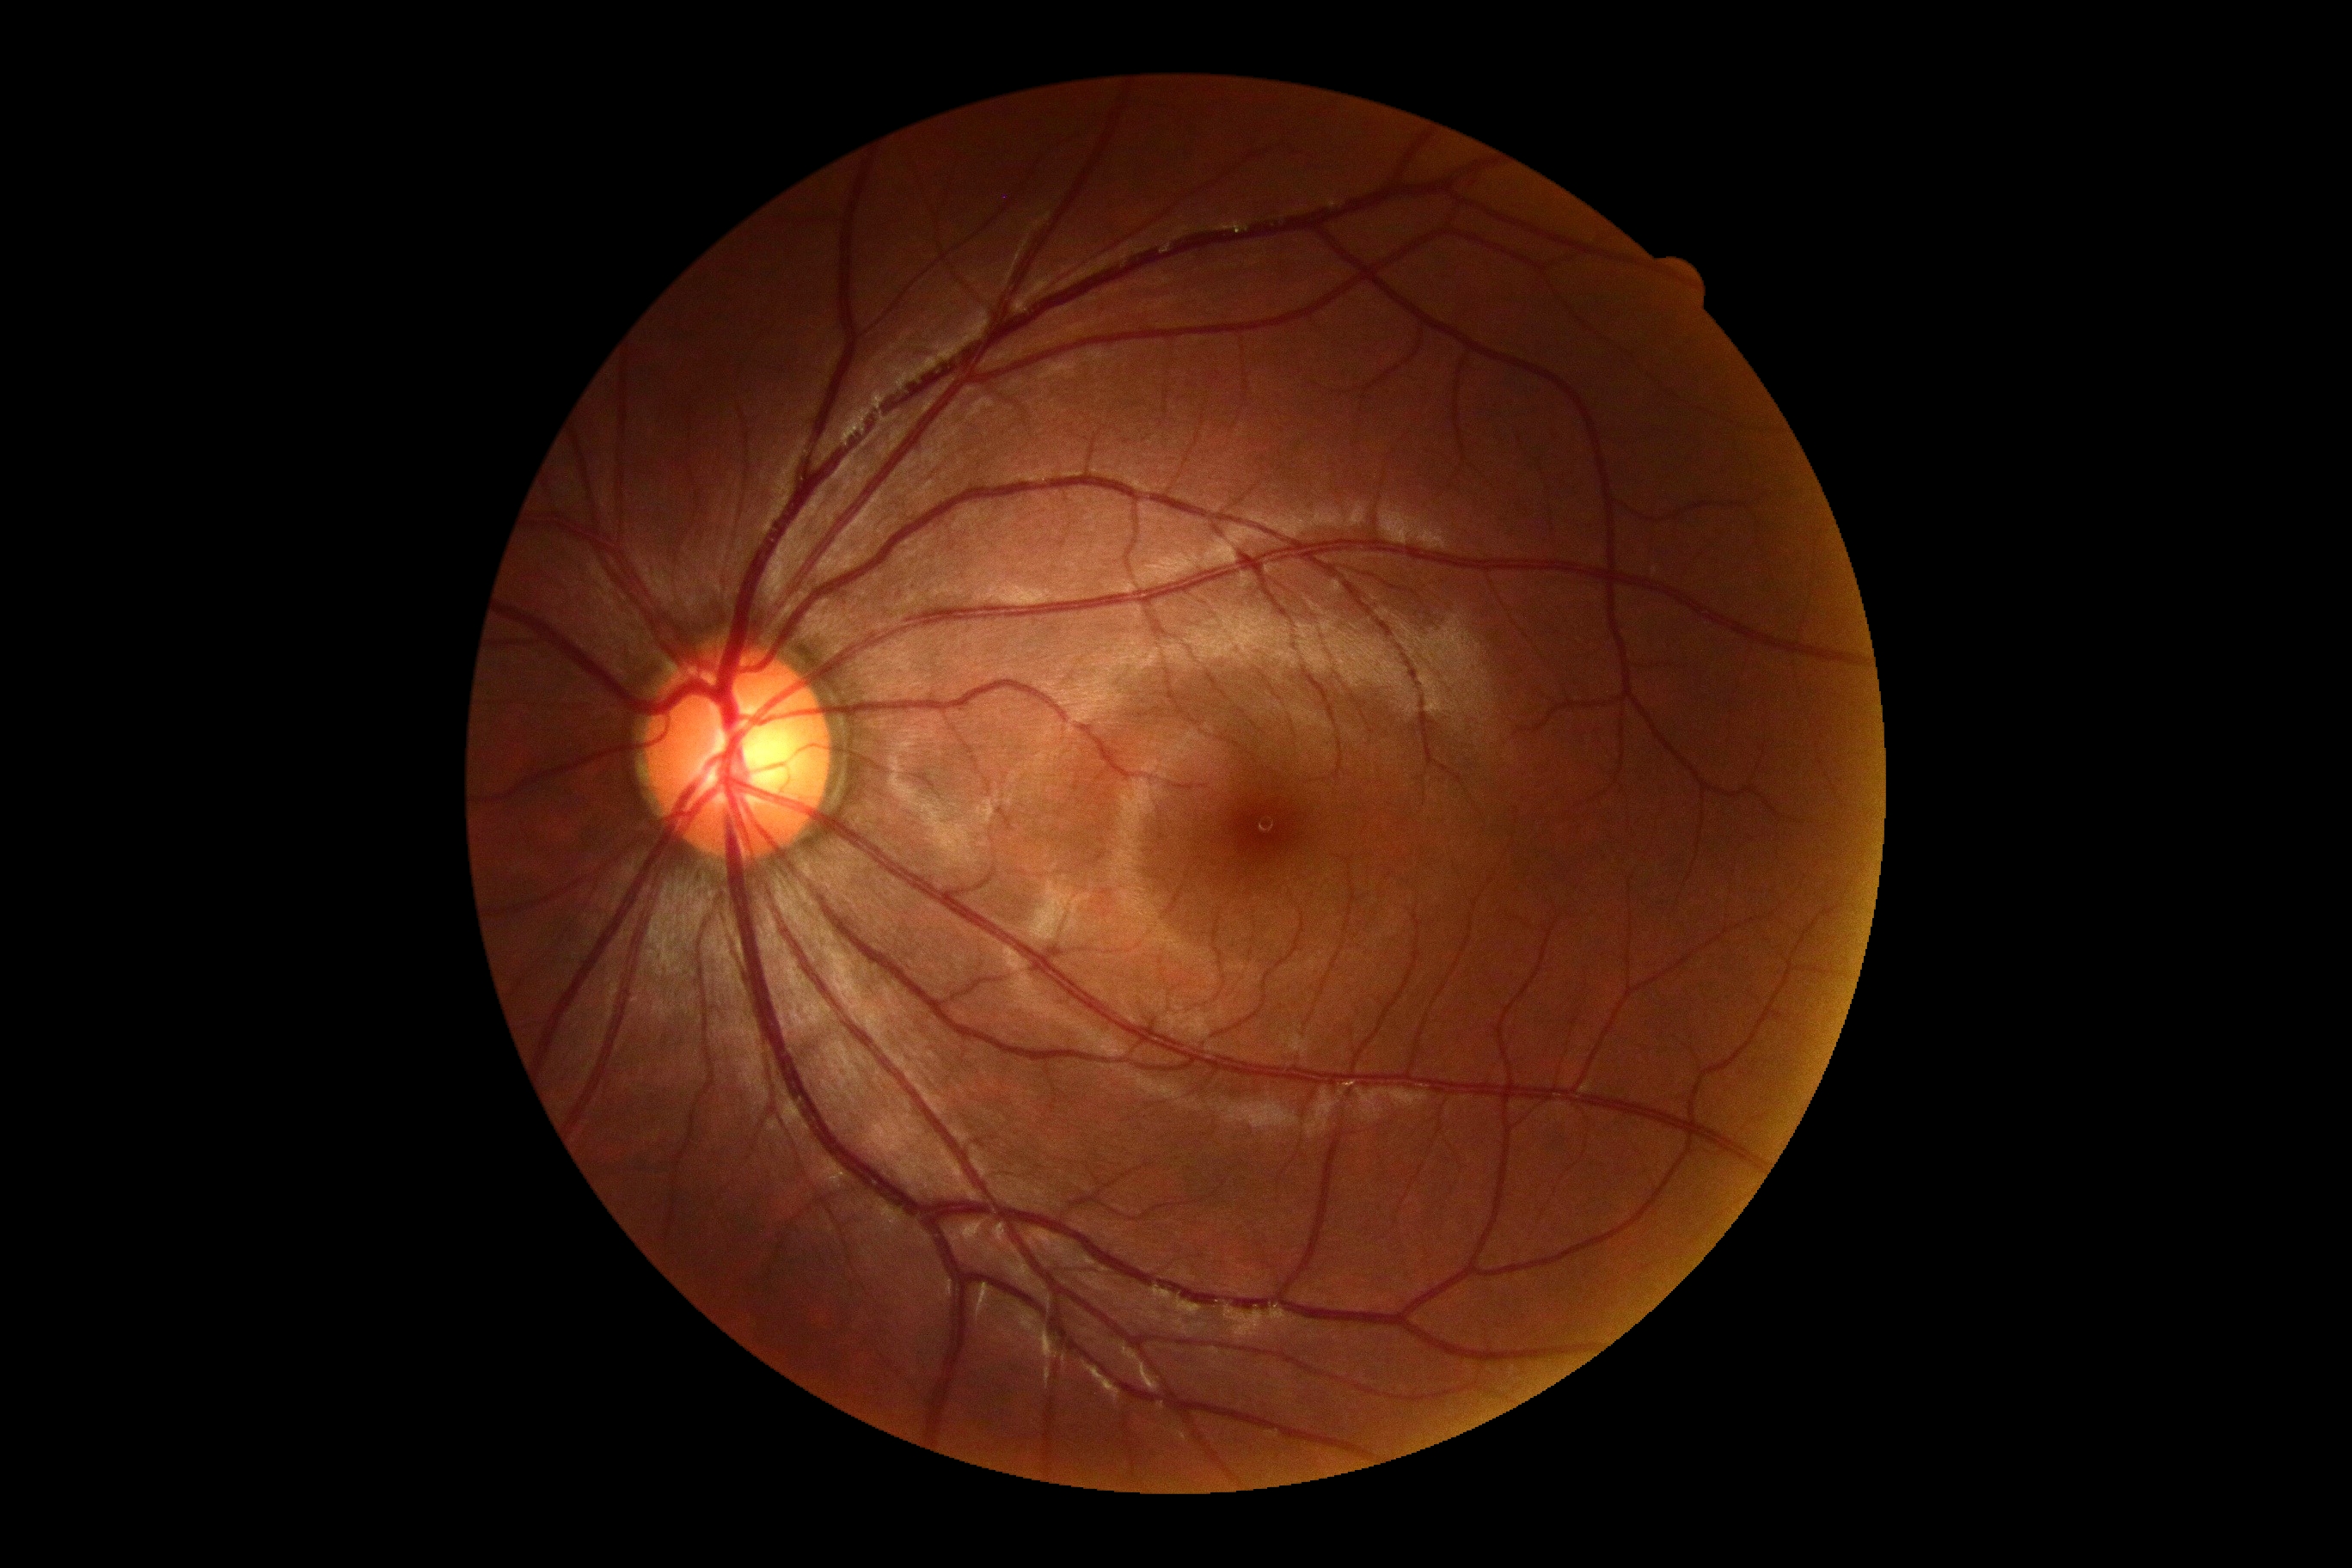

DR stage: no apparent retinopathy (grade 0).